Image size 848x848
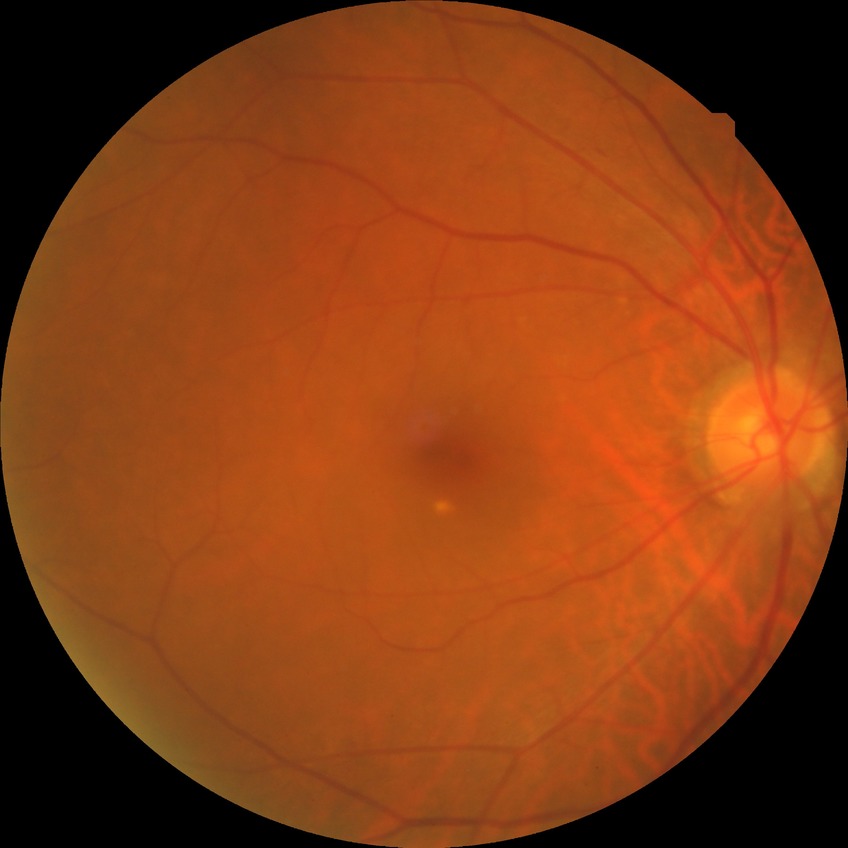 DR stage: SDR. The retinopathy is classified as non-proliferative diabetic retinopathy.